Nidek AFC-330.
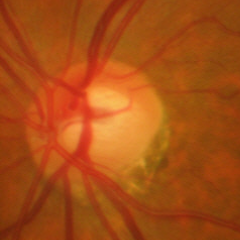

No glaucomatous changes.